NIDEK AFC-230 fundus camera. Image size 848x848. FOV: 45 degrees:
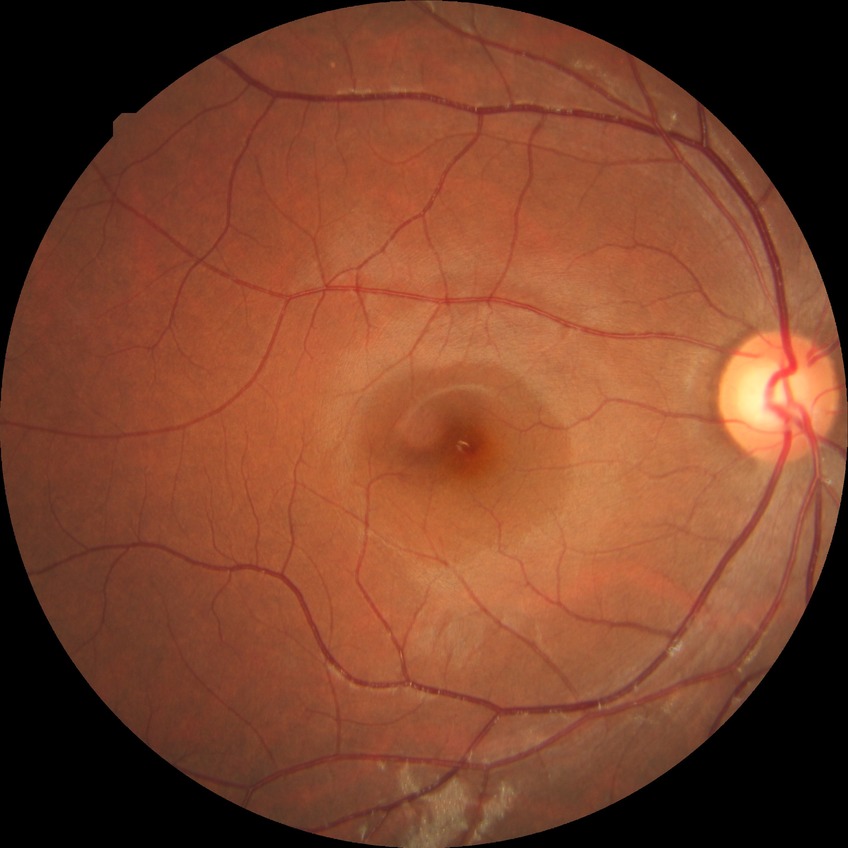
Diabetic retinopathy grade: no diabetic retinopathy.